848 x 848 pixels. Camera: NIDEK AFC-230. Without pupil dilation — 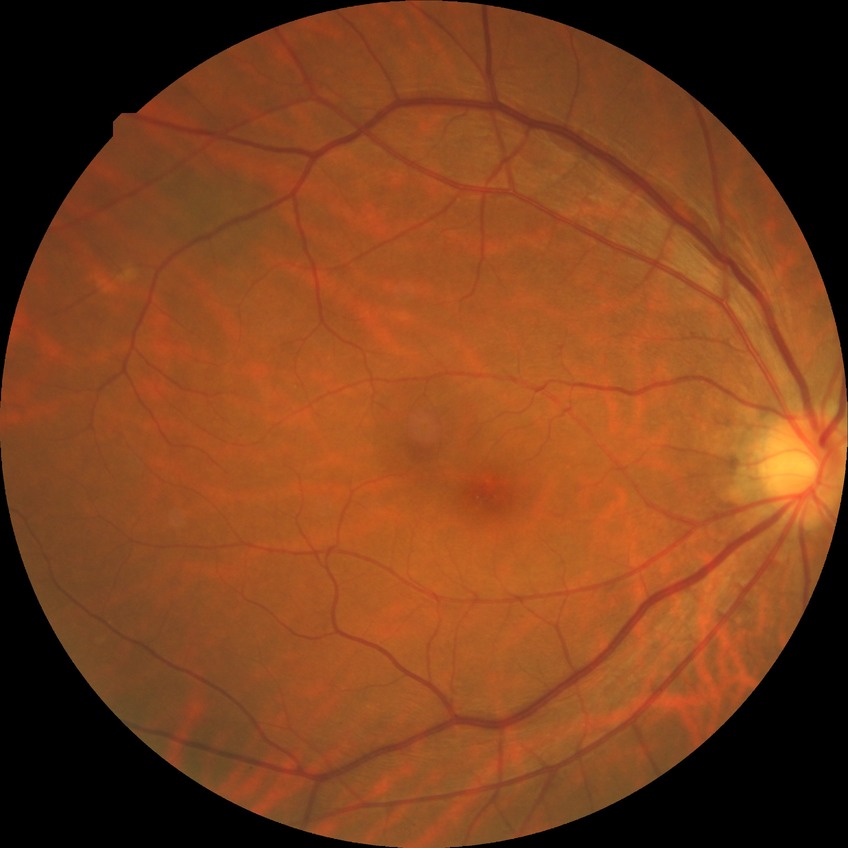
Diabetic retinopathy (DR): NDR (no diabetic retinopathy).